Color fundus photograph.
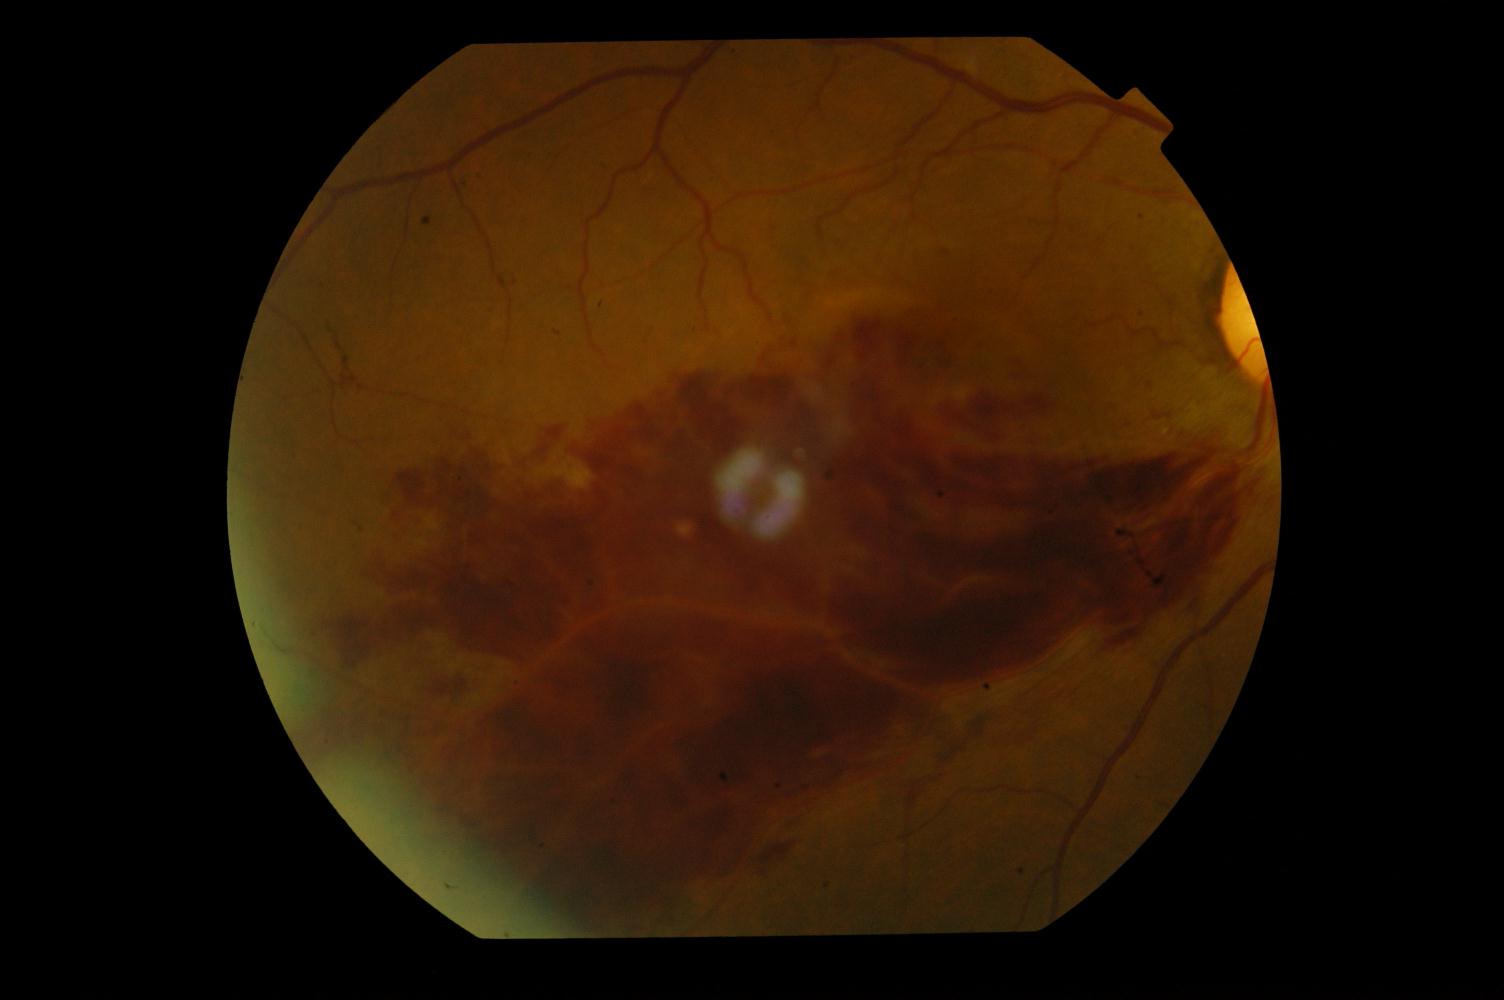

Diagnosis: branch retinal vein occlusion.